Posterior pole field covering the optic disc and macula, image size 2228x1652:
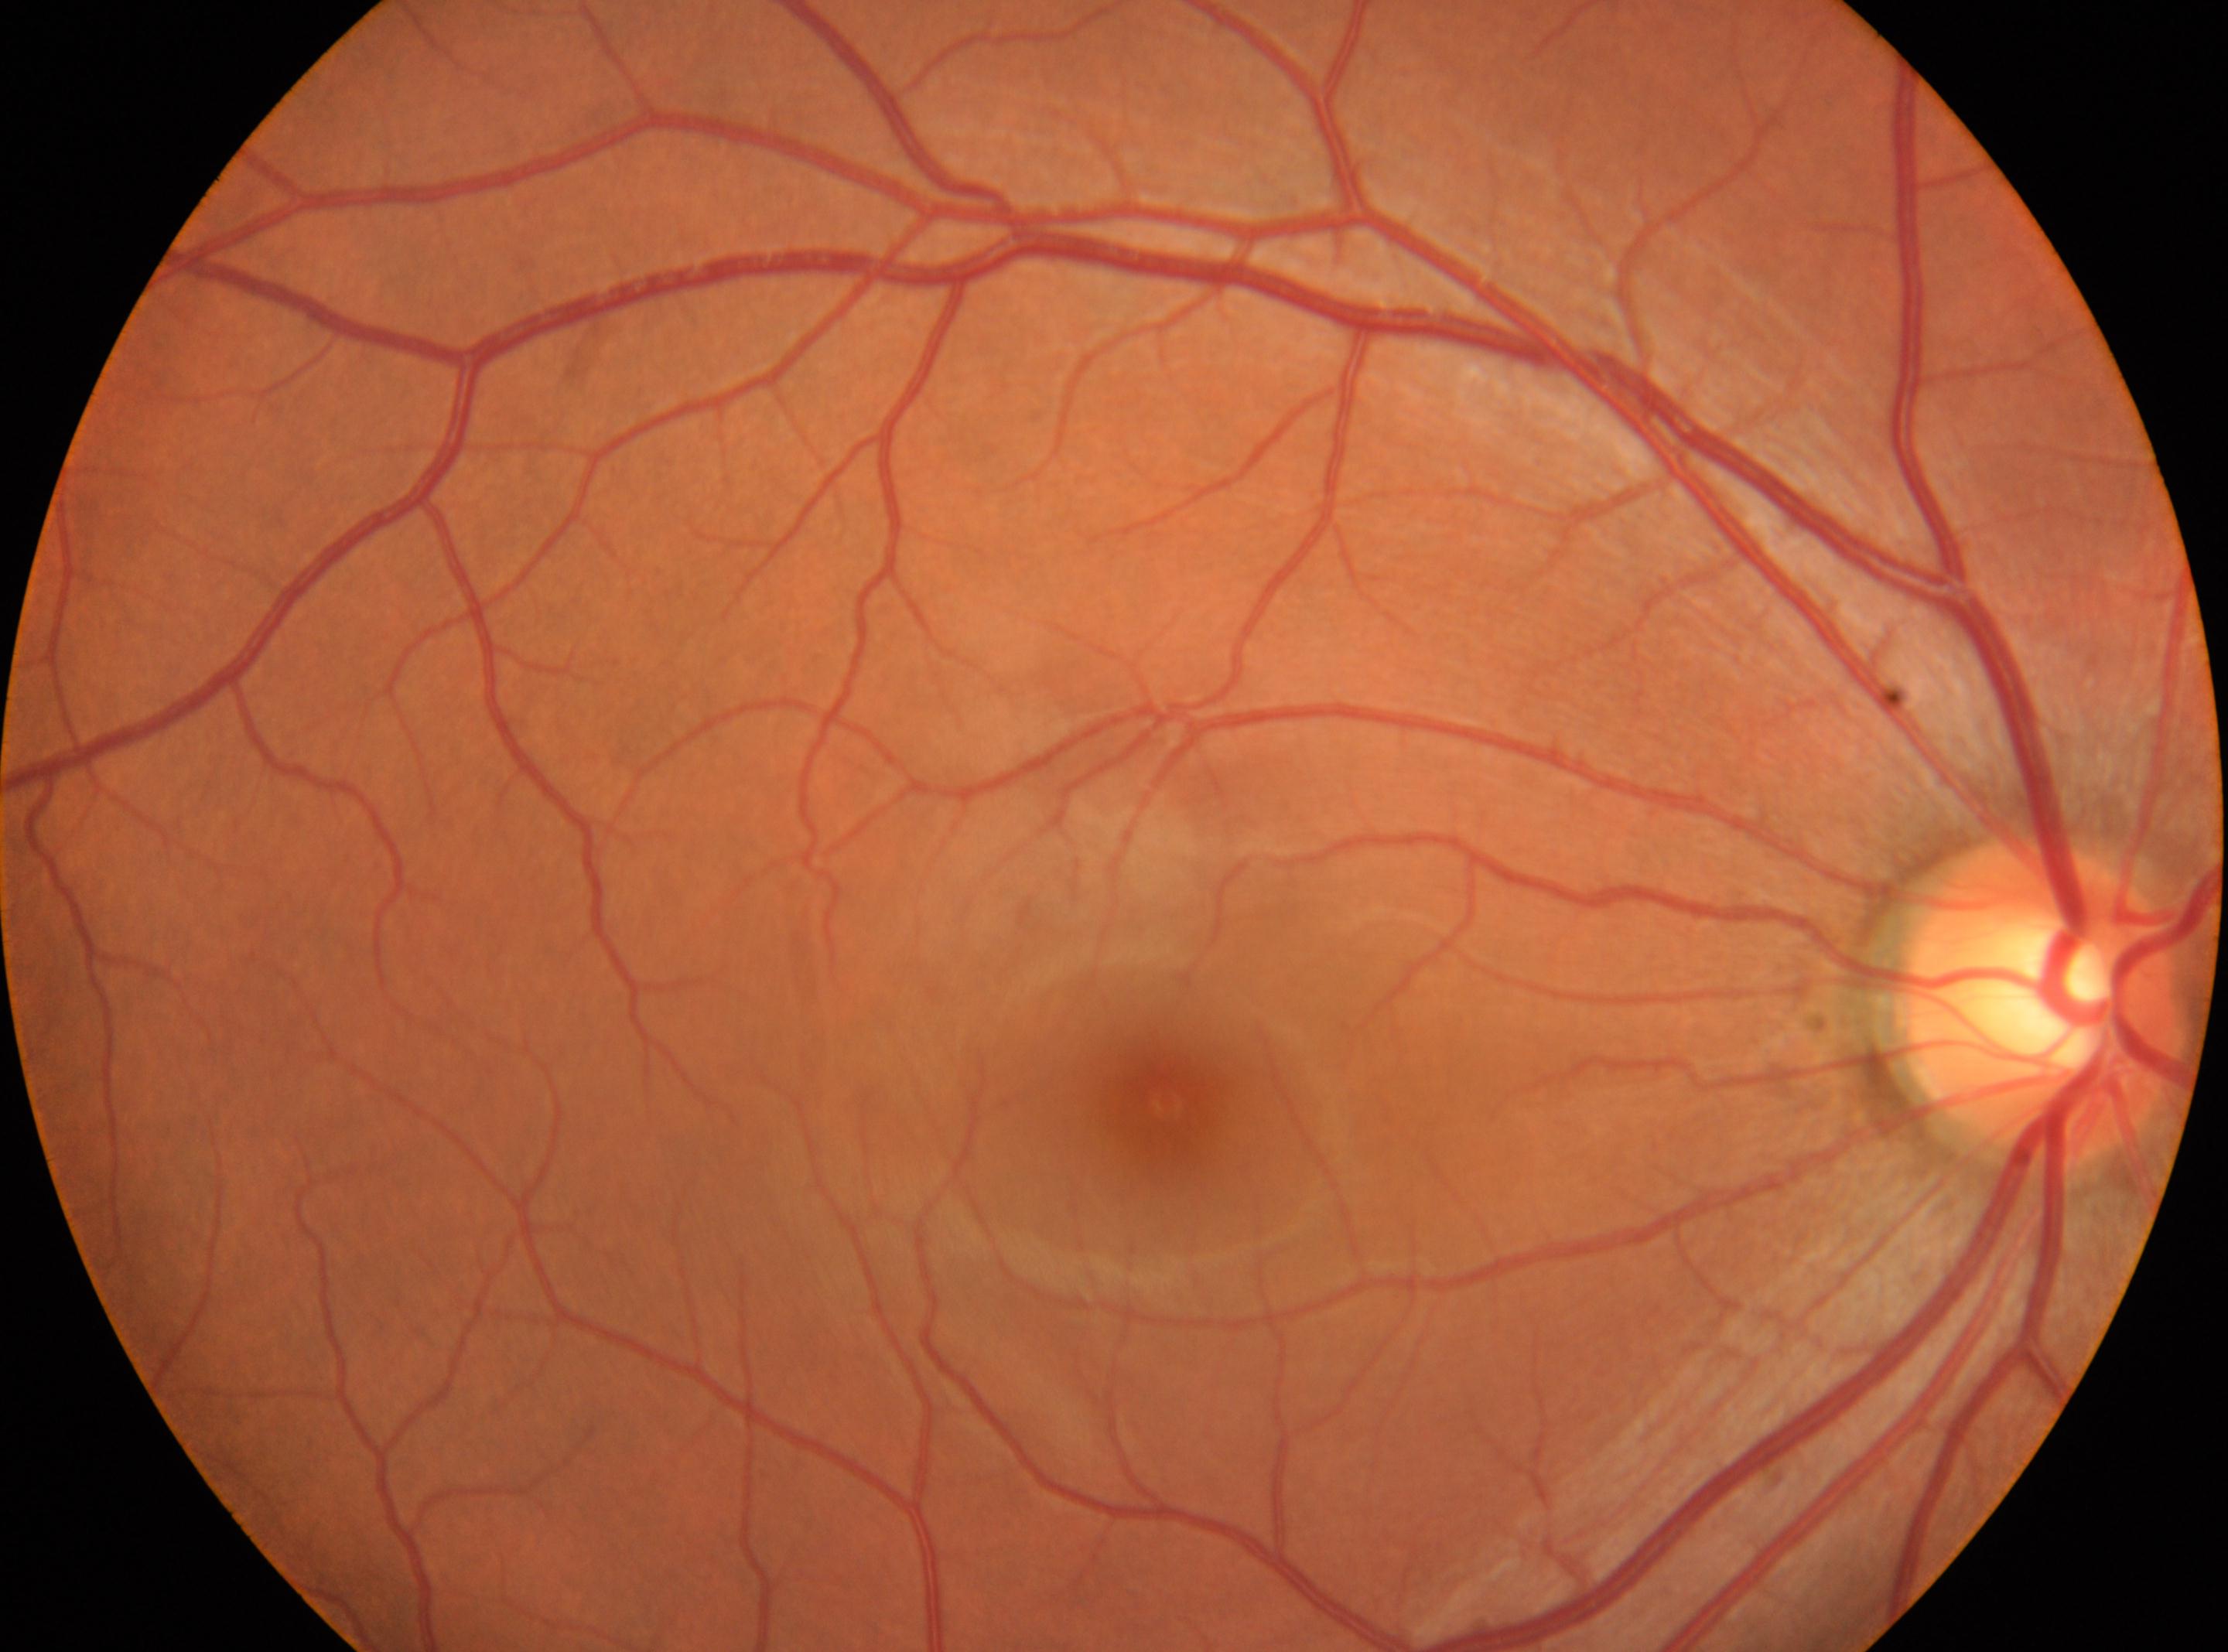
The disc center is at x=2041, y=998. The fovea center is at x=1167, y=1103. The image shows the right eye. Diabetic retinopathy grade: 0 (no apparent retinopathy).